Posterior pole photograph · DR severity per modified Davis staging — 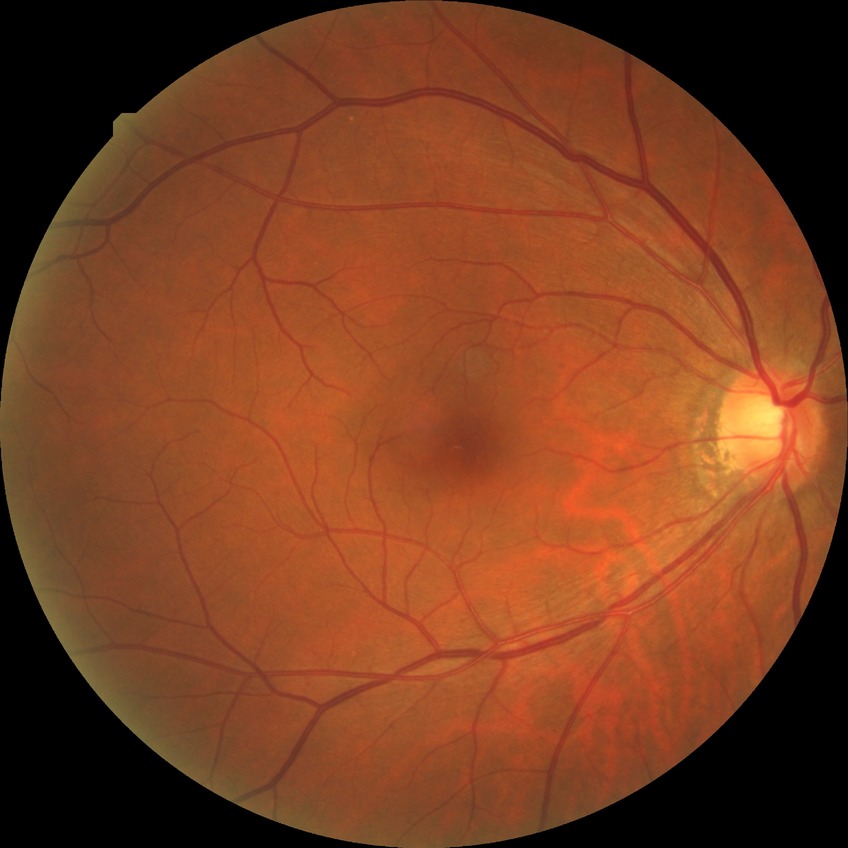
Diabetic retinopathy (DR): NDR (no diabetic retinopathy).